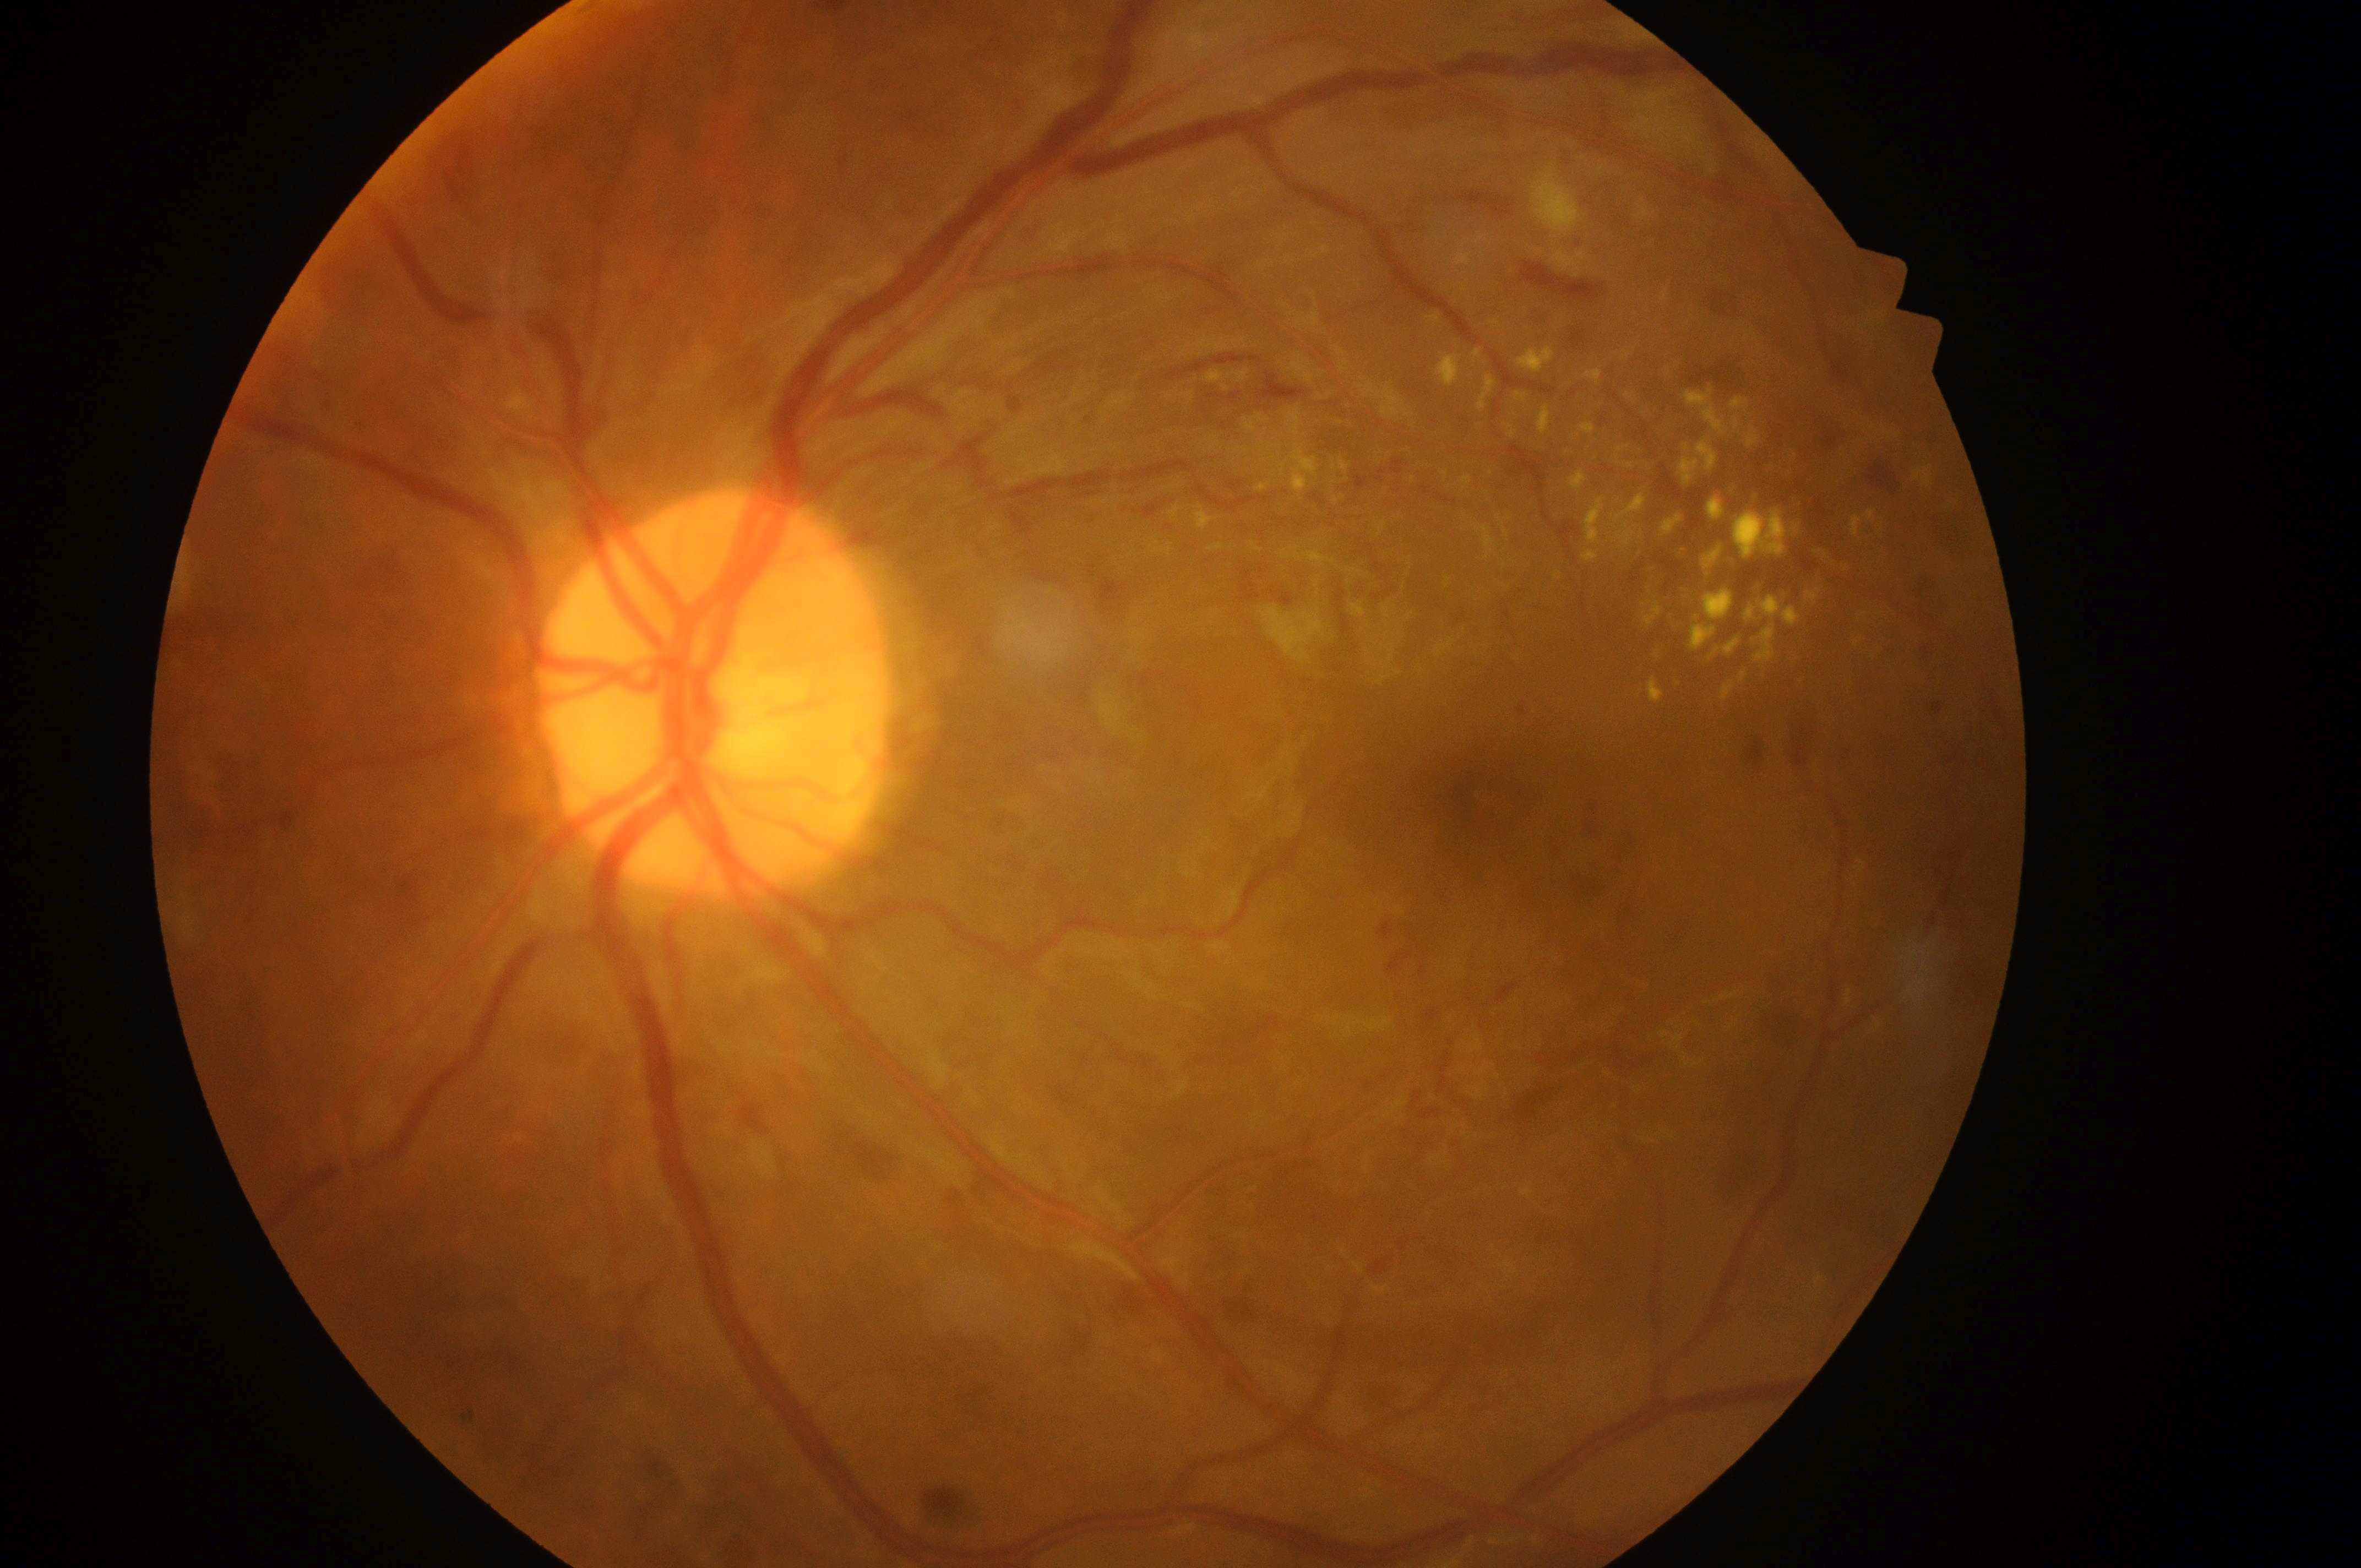
• diabetic macular edema (DME) — grade 2 (high risk)
• laterality — left eye
• diabetic retinopathy (DR) — grade 3 (severe NPDR)
• ONH — 711, 707
• macular center — 1475, 800